Fundus photo, 45° FOV, 1932 by 1910 pixels
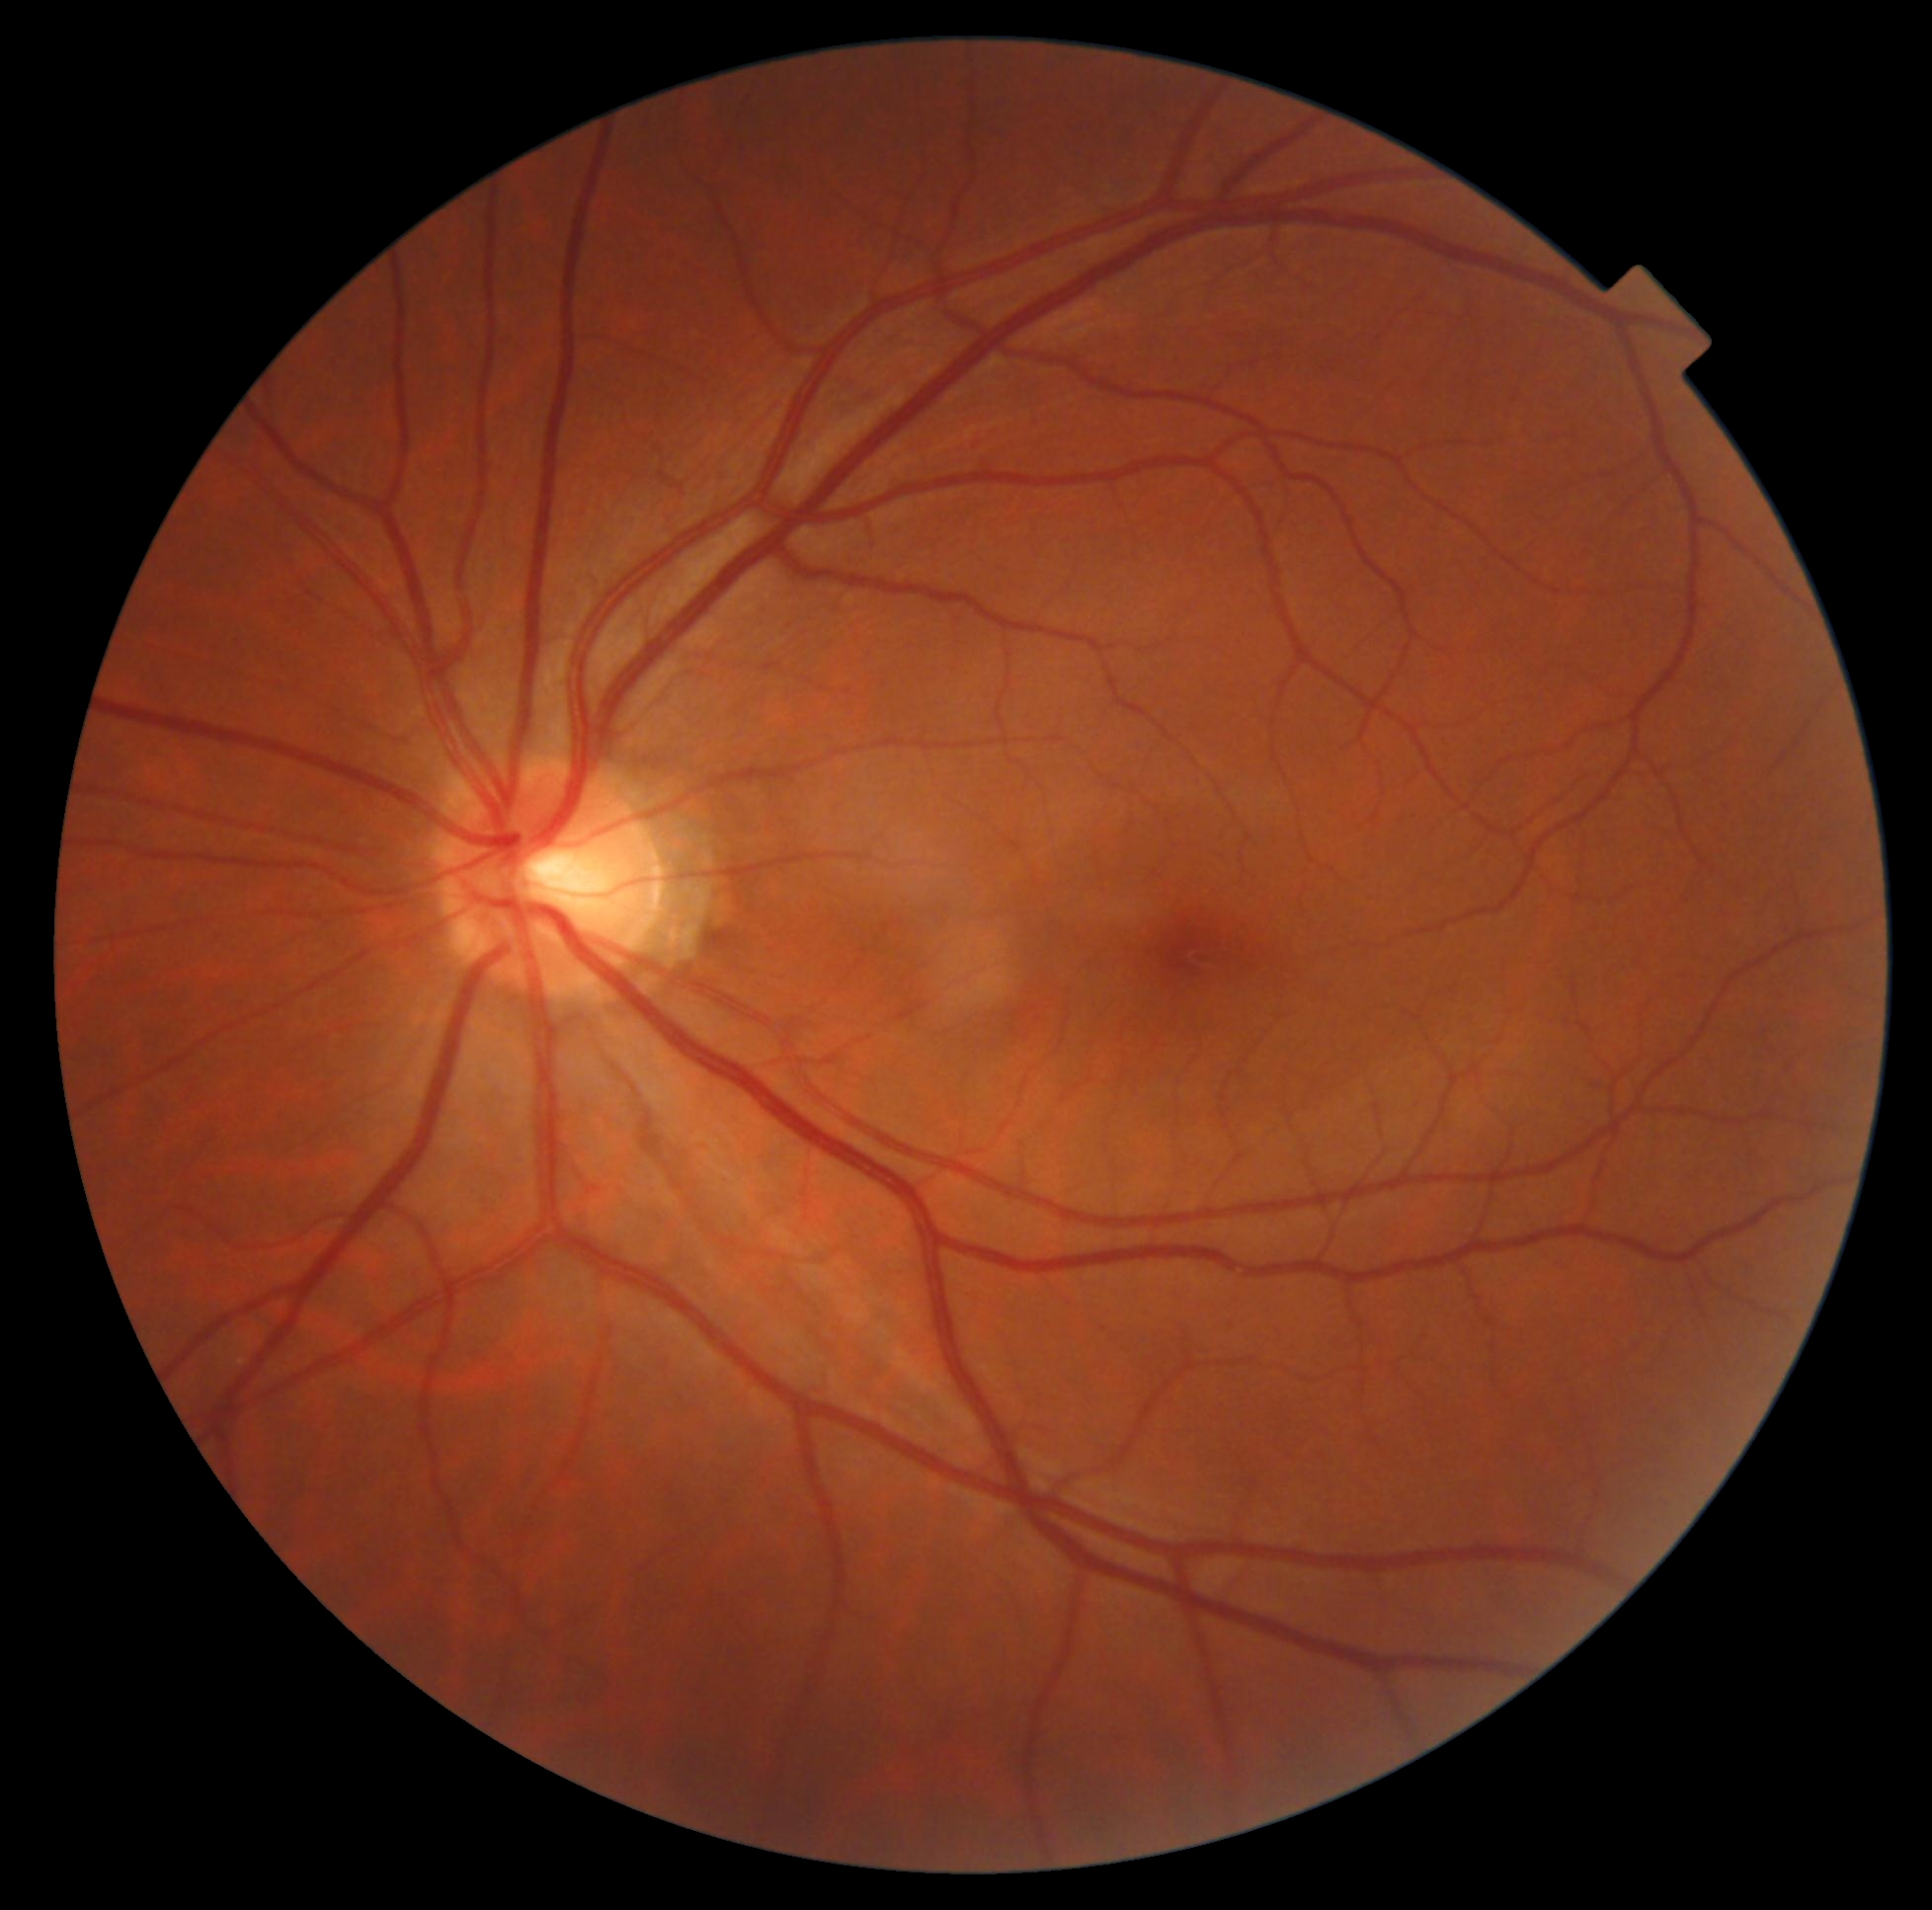

DR stage: grade 0.